Camera: NIDEK AFC-230; color fundus image; 45° FOV — 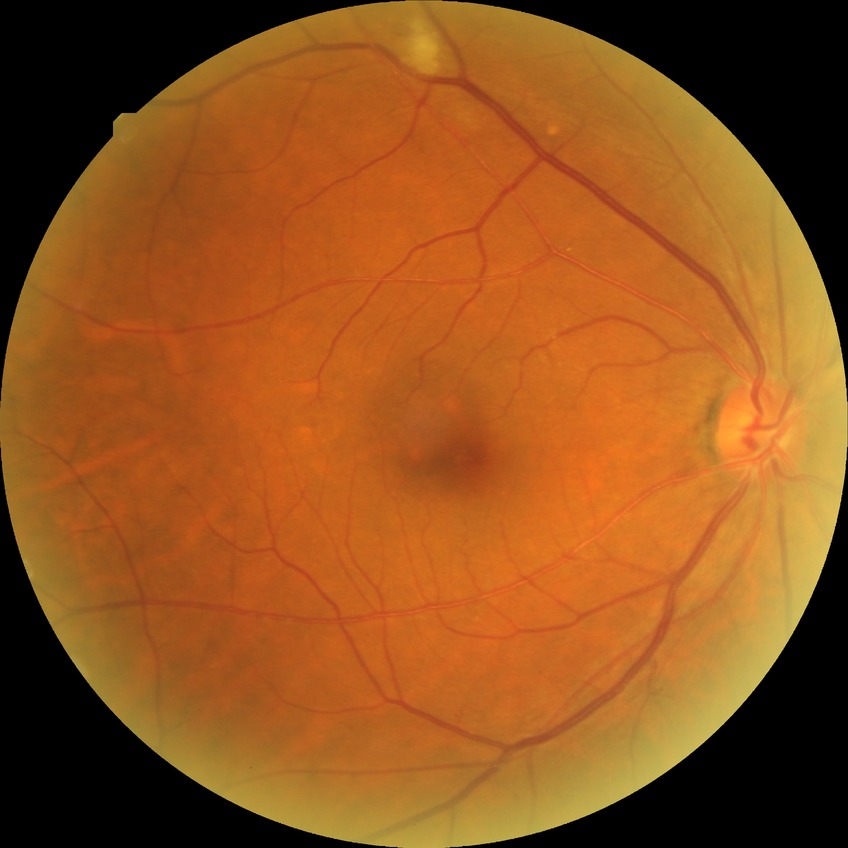 Retinopathy stage: pre-proliferative diabetic retinopathy.